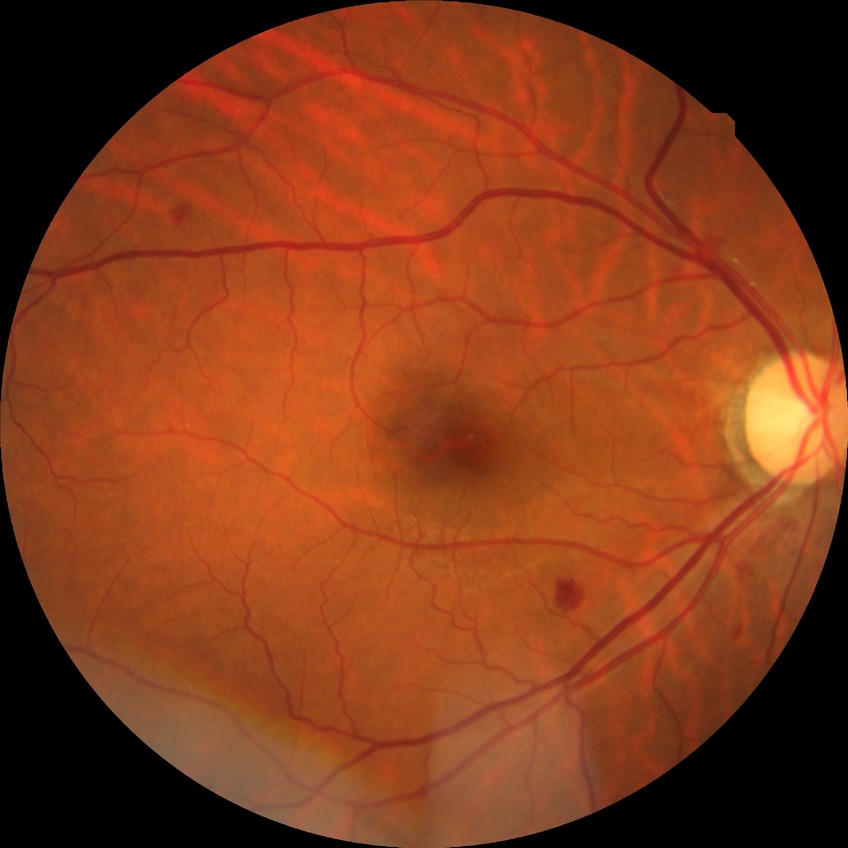 Diabetic retinopathy grade is simple diabetic retinopathy.